CFP. NIDEK AFC-230 fundus camera. 848 by 848 pixels. No pharmacologic dilation. 45° FOV — 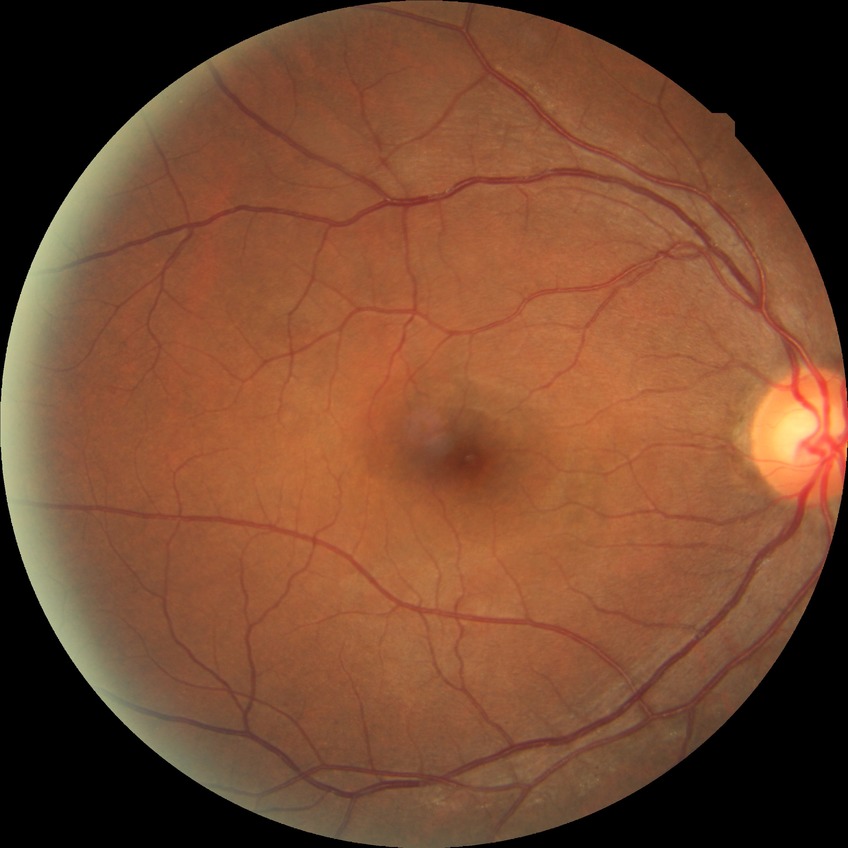

DR stage is NDR.